Captured without pupil dilation; acquired with a Nidek AFC-330; retinal fundus photograph: 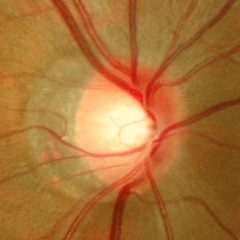
Q: What stage of glaucoma is present?
A: Early glaucoma. (Criteria: glaucomatous retinal nerve fiber layer defects on red-free fundus photography without visual field defects.)